Infant wide-field retinal image: 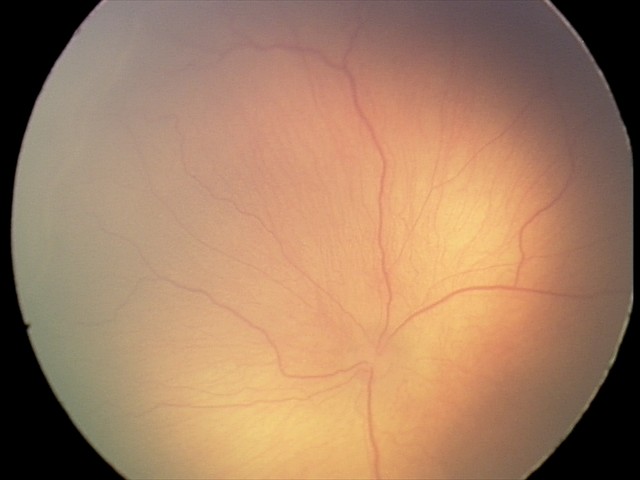

Plus disease absent. From an examination with diagnosis of ROP stage 1.